Macula-centered. 1932x1932: 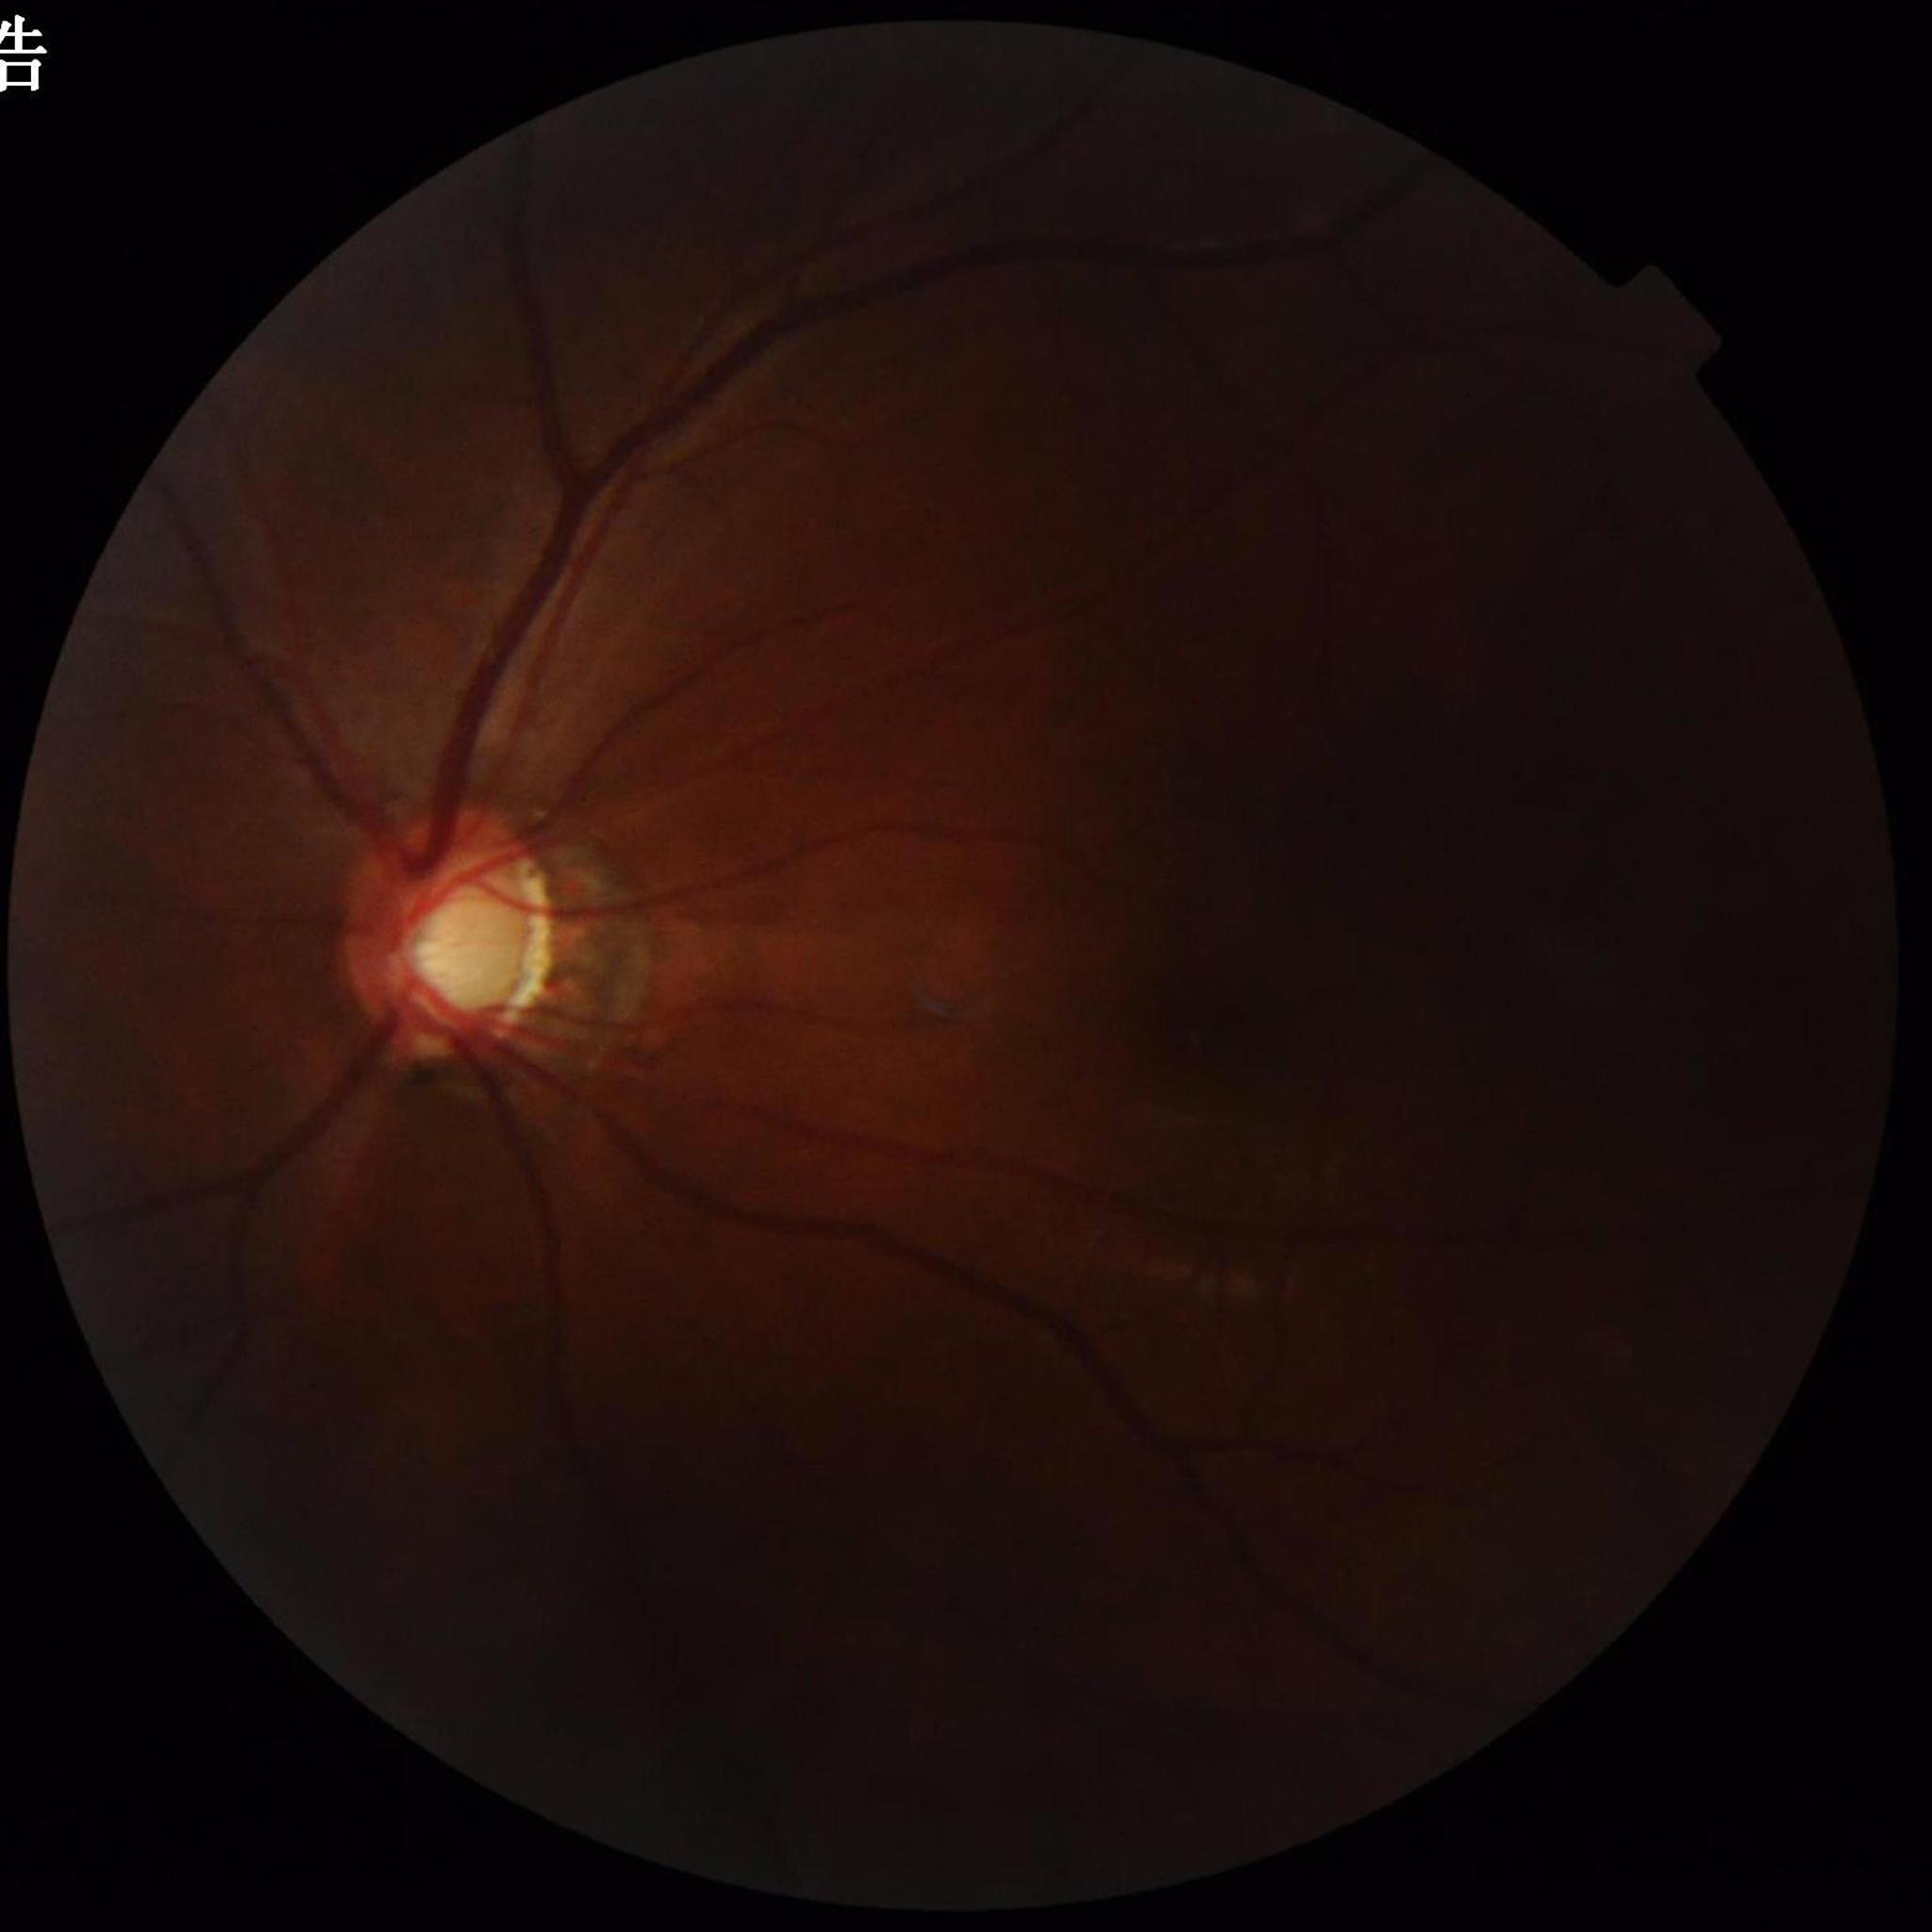
Image quality: illumination/color distortion present, contrast adequate, no blur. The patient was diagnosed with glaucoma.